Image size 2048x1536 · color fundus image
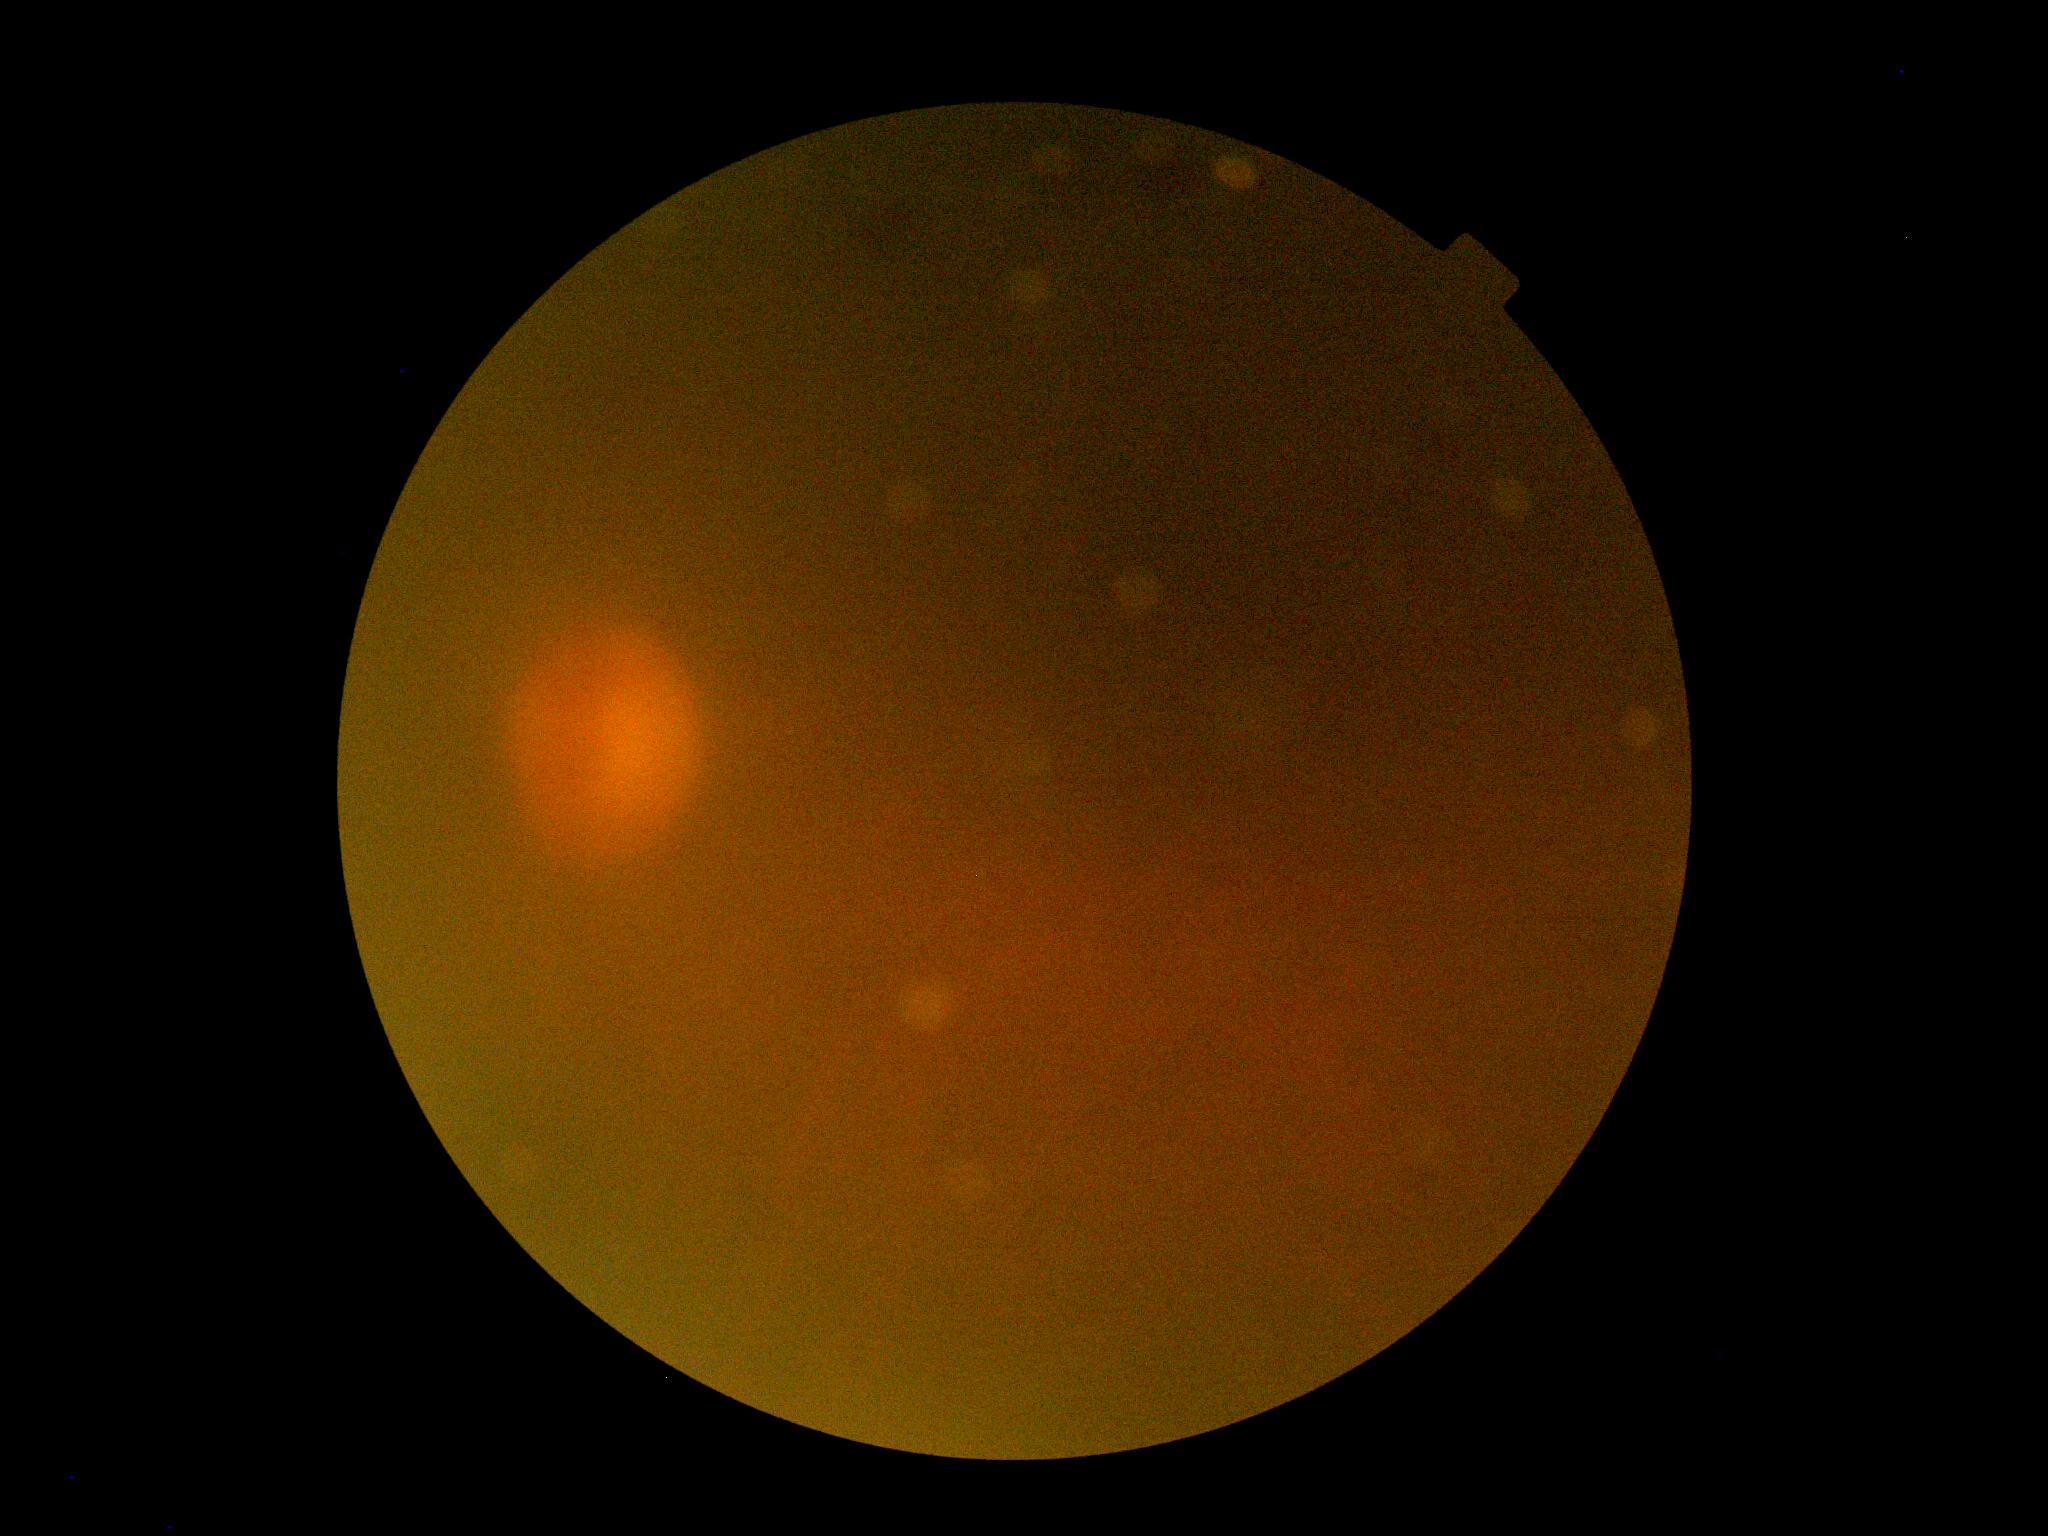
Findings:
• DR severity: ungradable
• image quality: insufficient for DR assessment